Tabletop color fundus camera image — 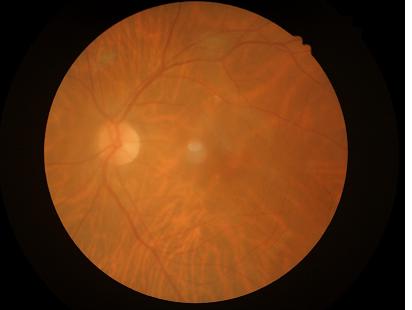
The image is blurry. Vessels and details are readily distinguishable. Image quality is suboptimal.